45° field of view, fundus photo
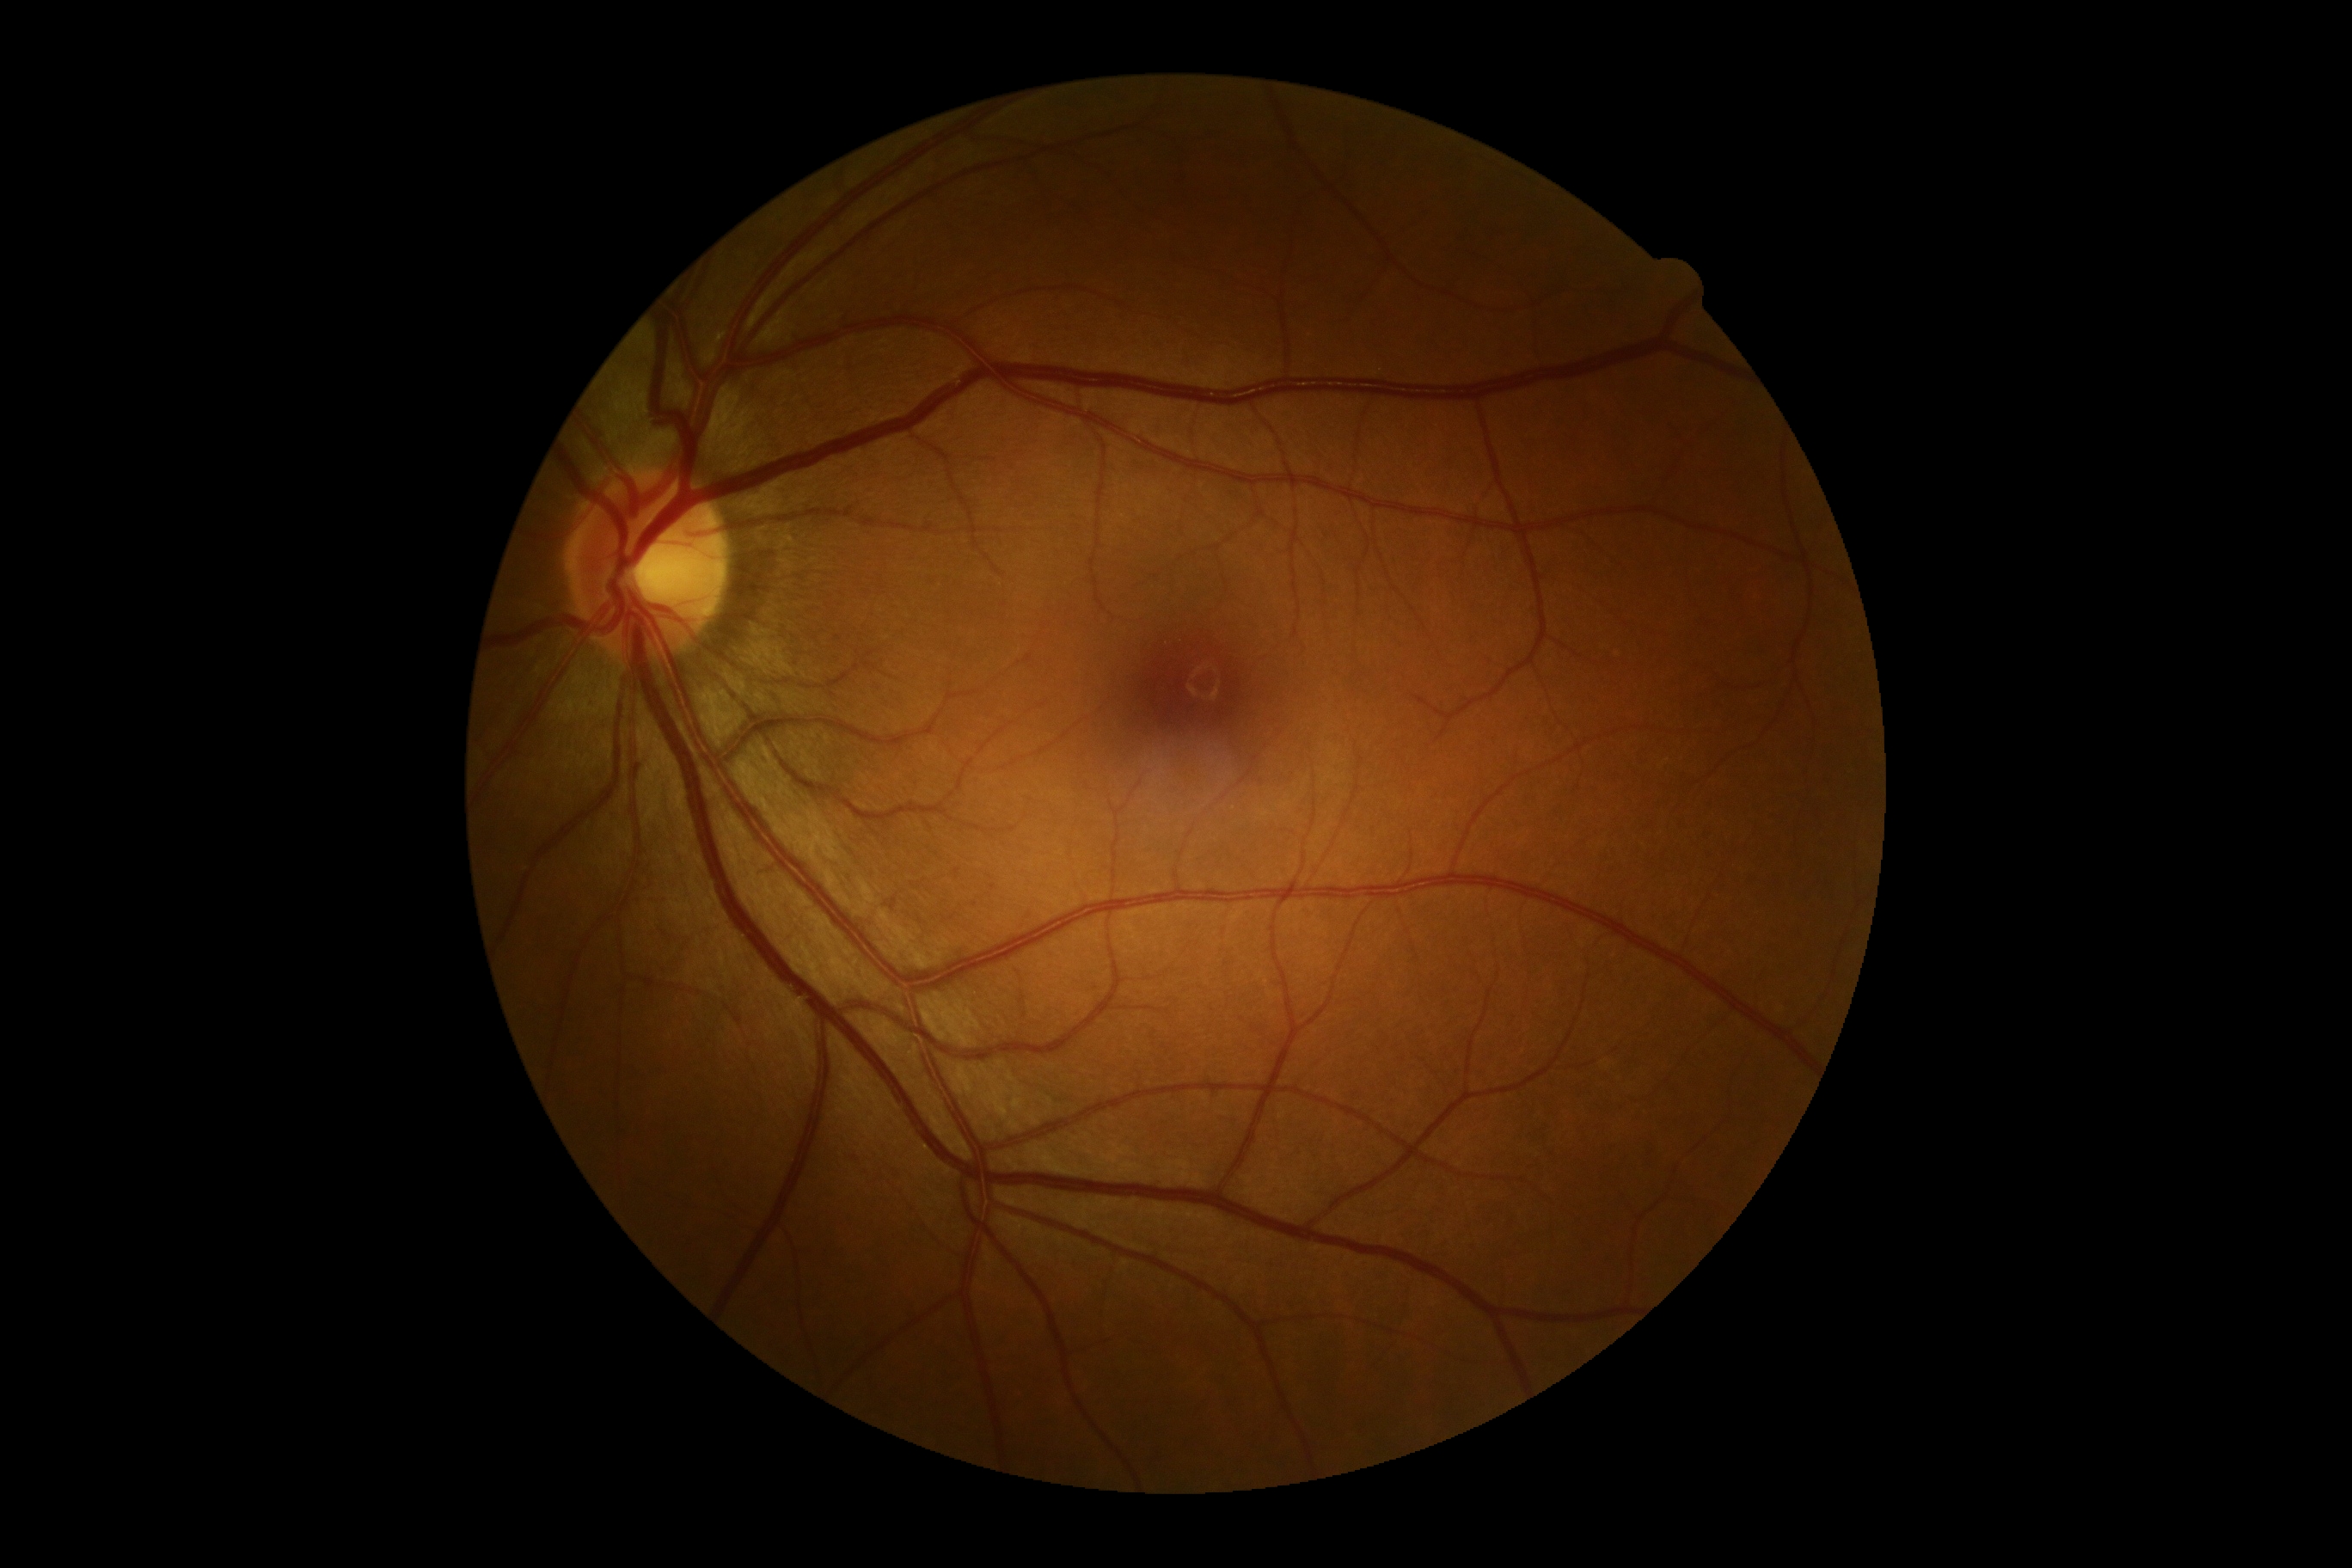

Diabetic retinopathy (DR): grade 0 (no apparent retinopathy).